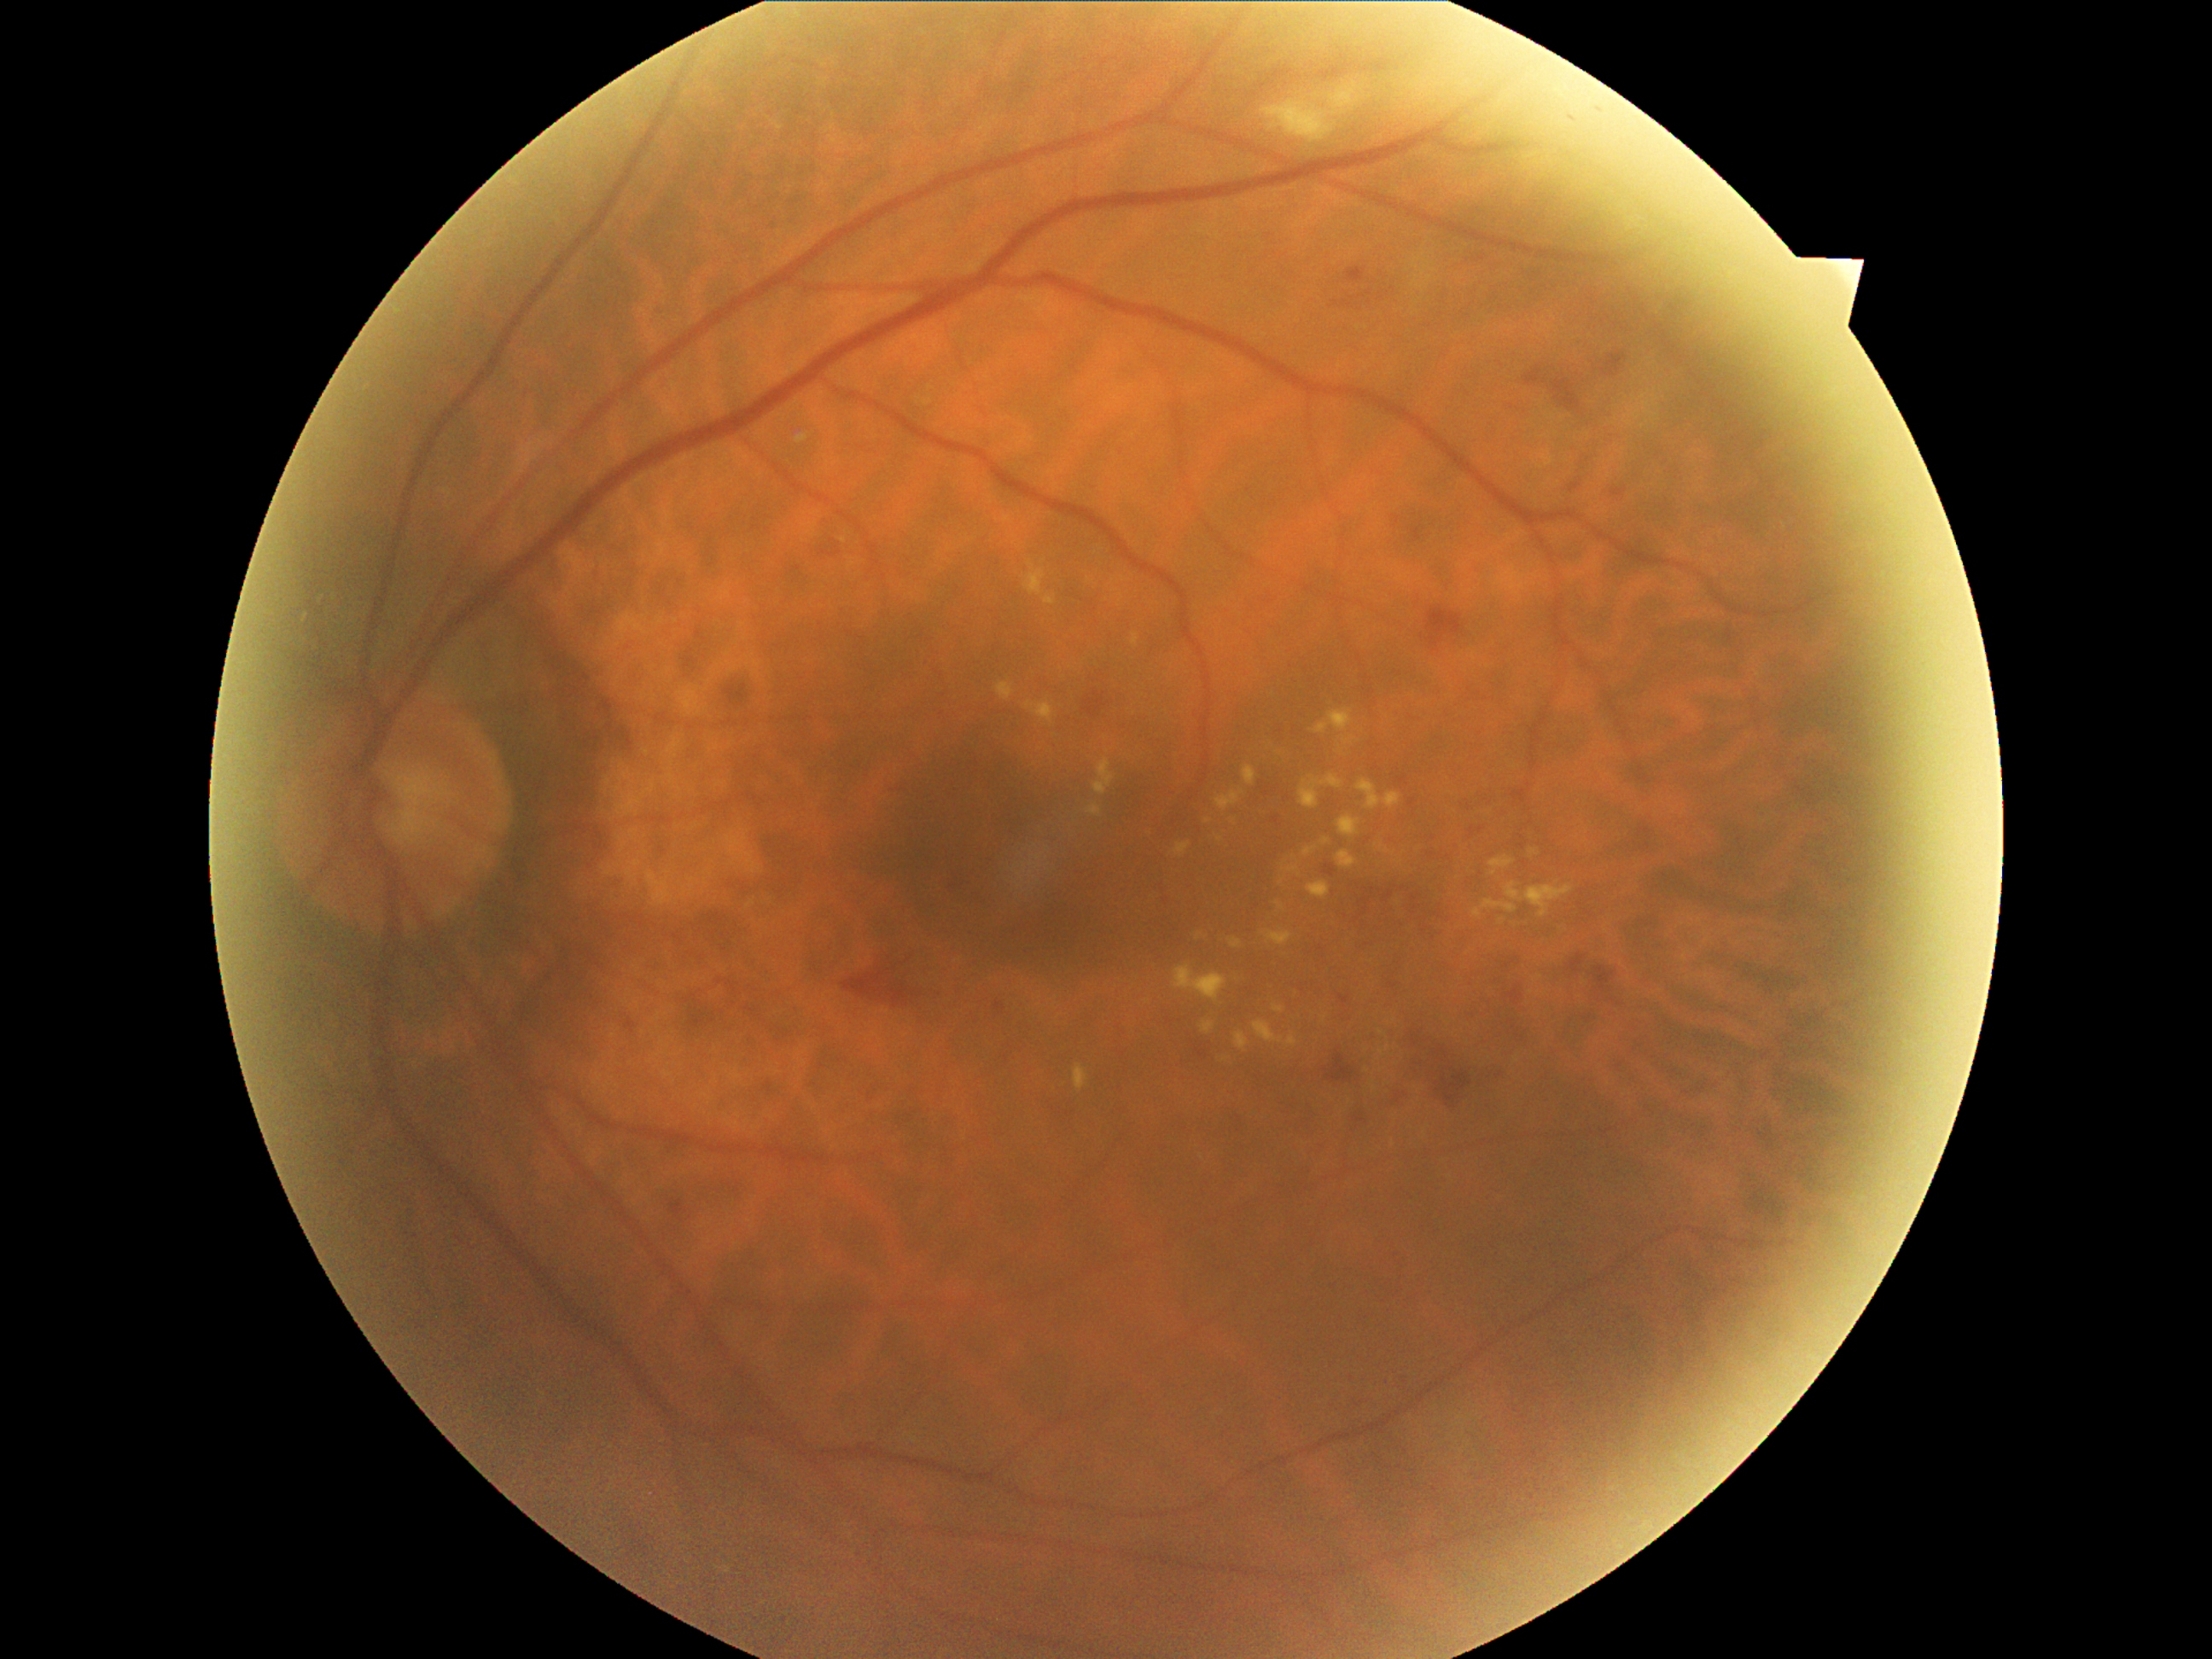
partial: true
dr_grade: 2
dr_grade_name: moderate NPDR
lesions:
  ex:
    - left=1472, top=899, right=1518, bottom=917
    - left=1322, top=837, right=1332, bottom=846
    - left=1385, top=793, right=1400, bottom=810
    - left=1358, top=779, right=1382, bottom=810
    - left=1230, top=940, right=1243, bottom=948
    - left=1342, top=736, right=1358, bottom=747
    - left=1267, top=931, right=1291, bottom=946
    - left=1173, top=965, right=1226, bottom=1003
    - left=1044, top=595, right=1057, bottom=607
    - left=1216, top=789, right=1245, bottom=812
    - left=1337, top=849, right=1358, bottom=870
  ex_small_centers:
    - (1281, 905)
    - (1398, 861)
    - (1533, 852)